45° field of view, fundus photo.
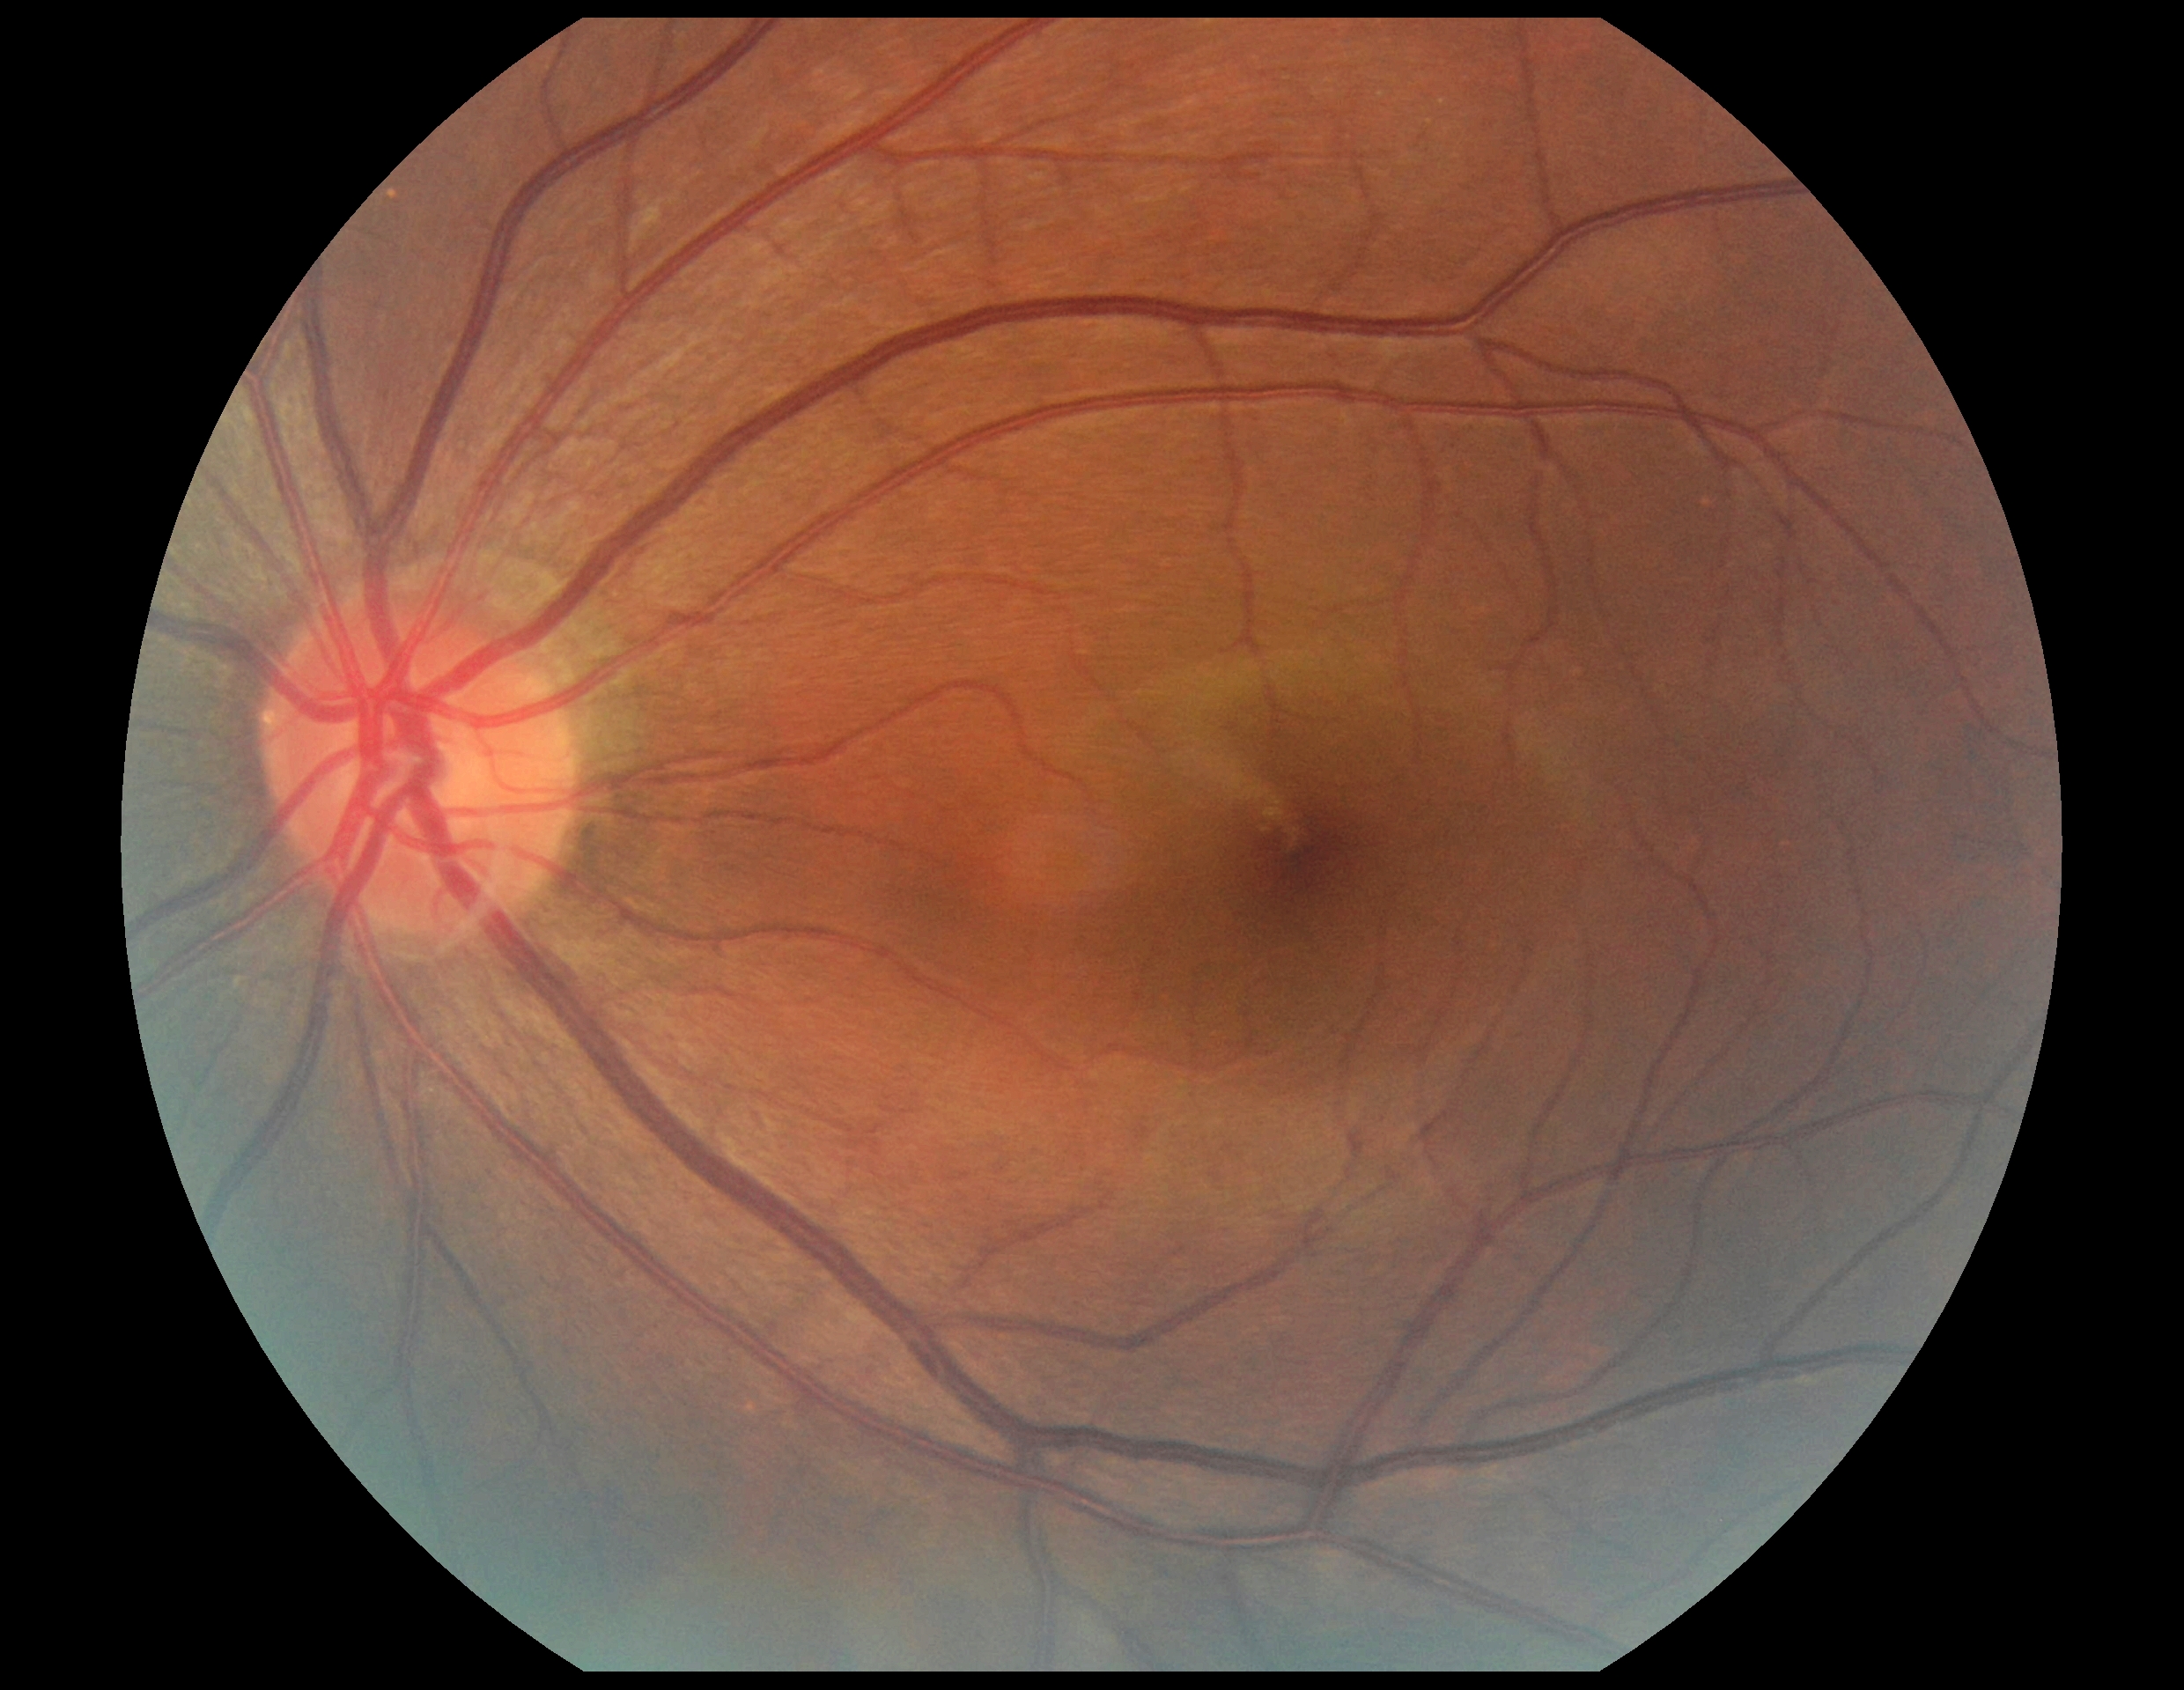 DR impression: no DR findings; diabetic retinopathy (DR): grade 0.